Captured with the Phoenix ICON (100° field of view) · 1240x1240 · Phoenix ICON wide-field infant fundus image — 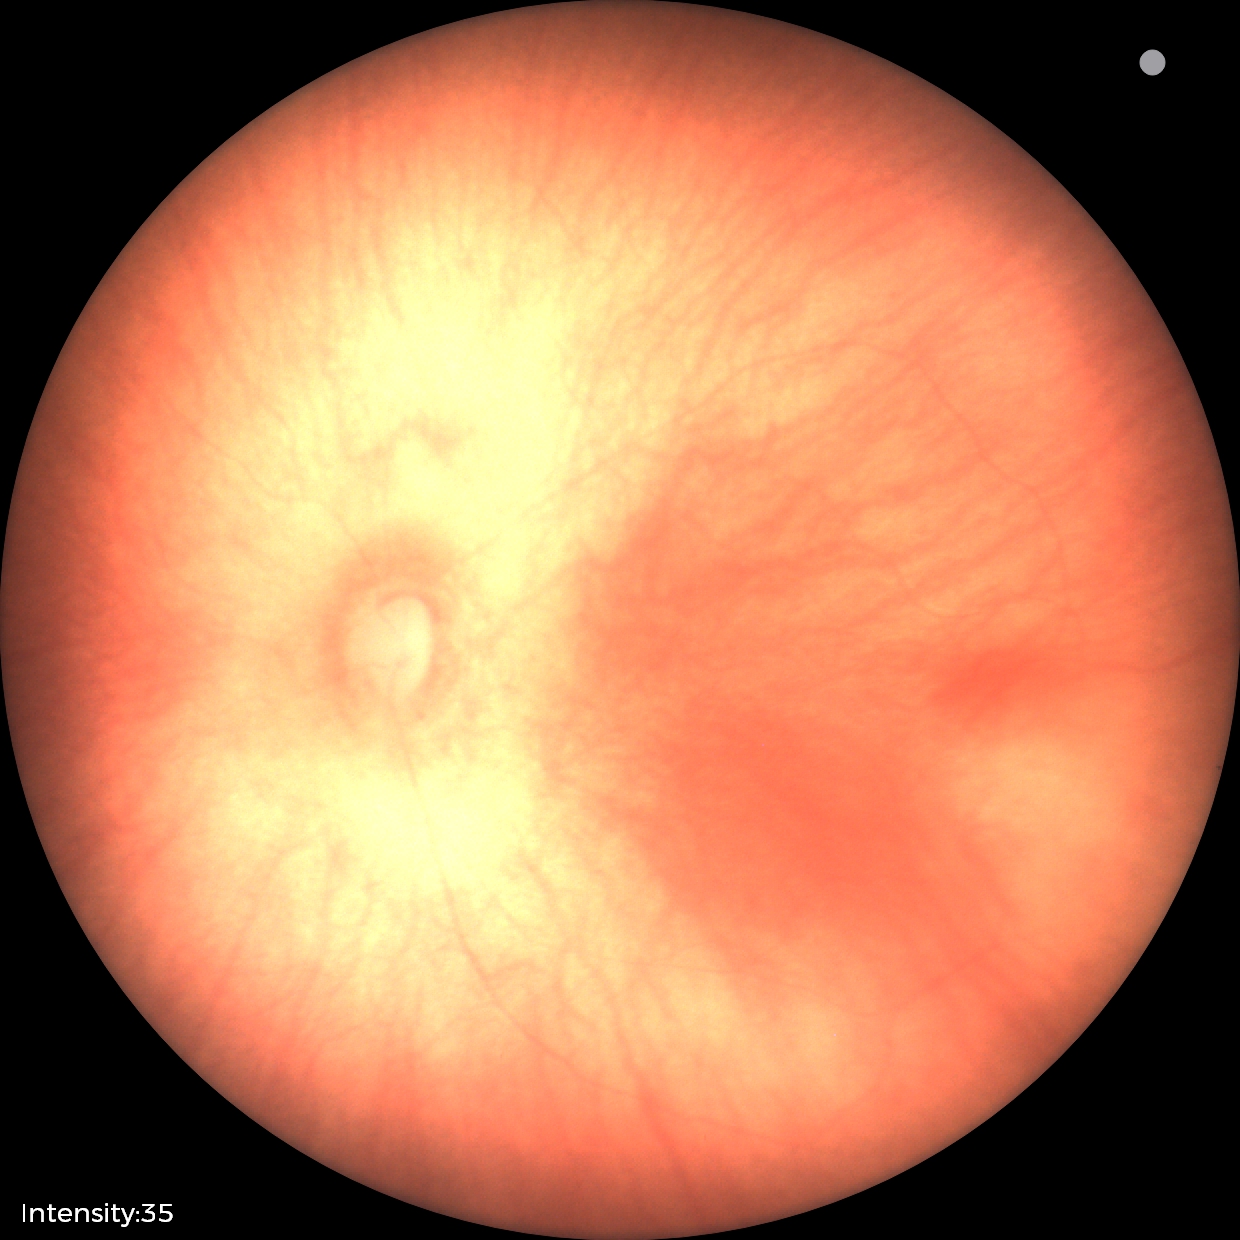 Assessment: normal.